45° FOV:
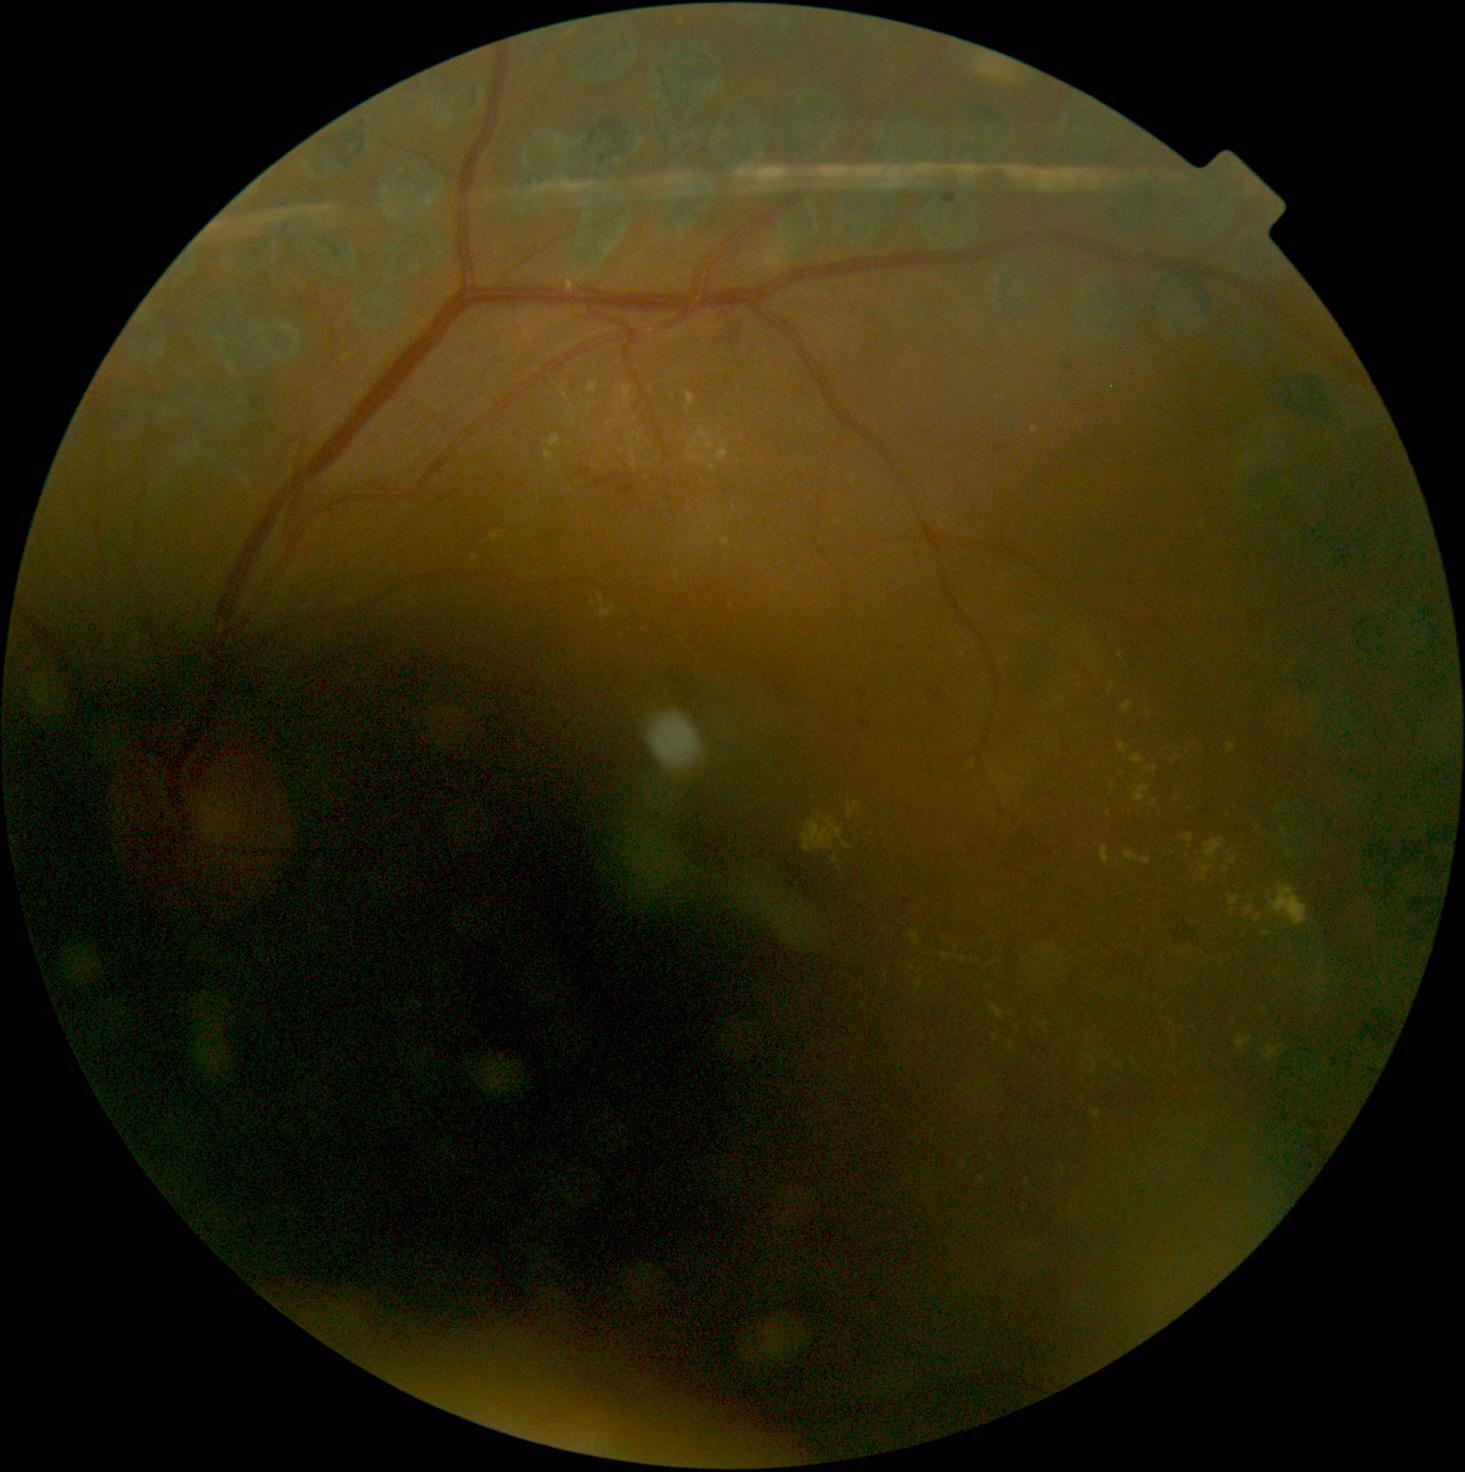 DR: moderate NPDR (grade 2) — more than just microaneurysms but less than severe NPDR.